1932x1910px. 45-degree field of view — 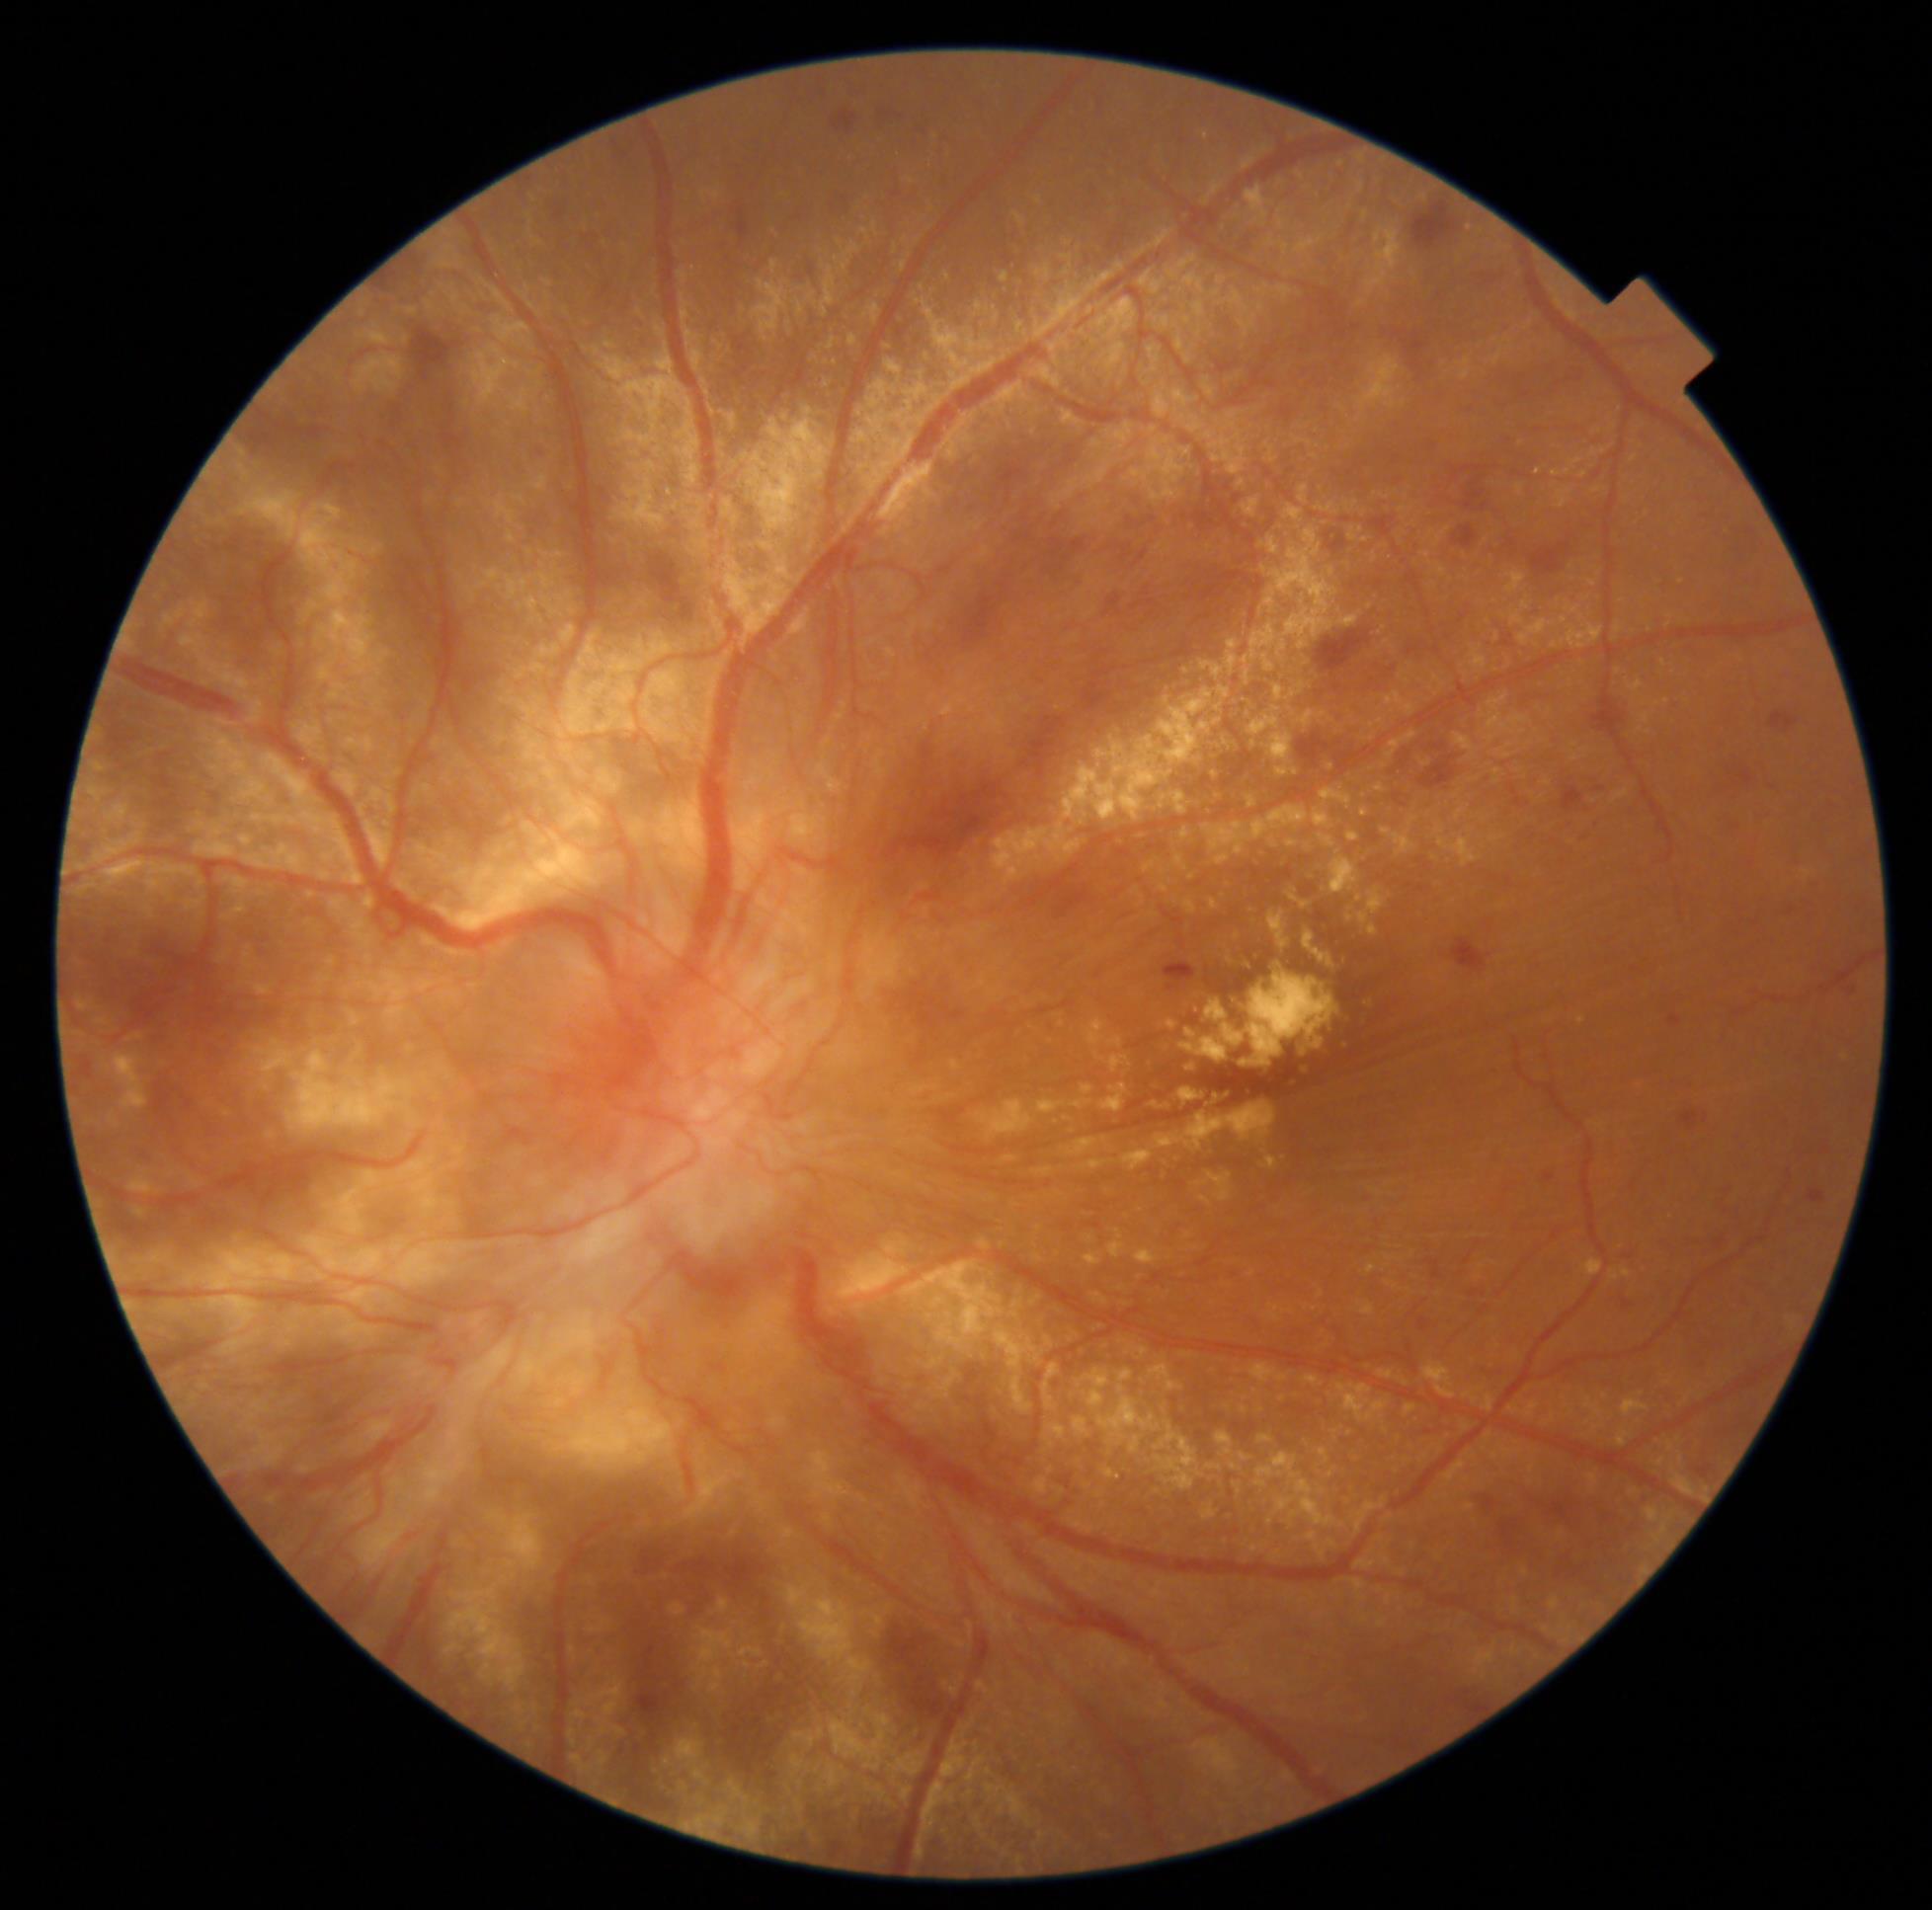 Diabetic retinopathy severity is proliferative diabetic retinopathy (grade 4).